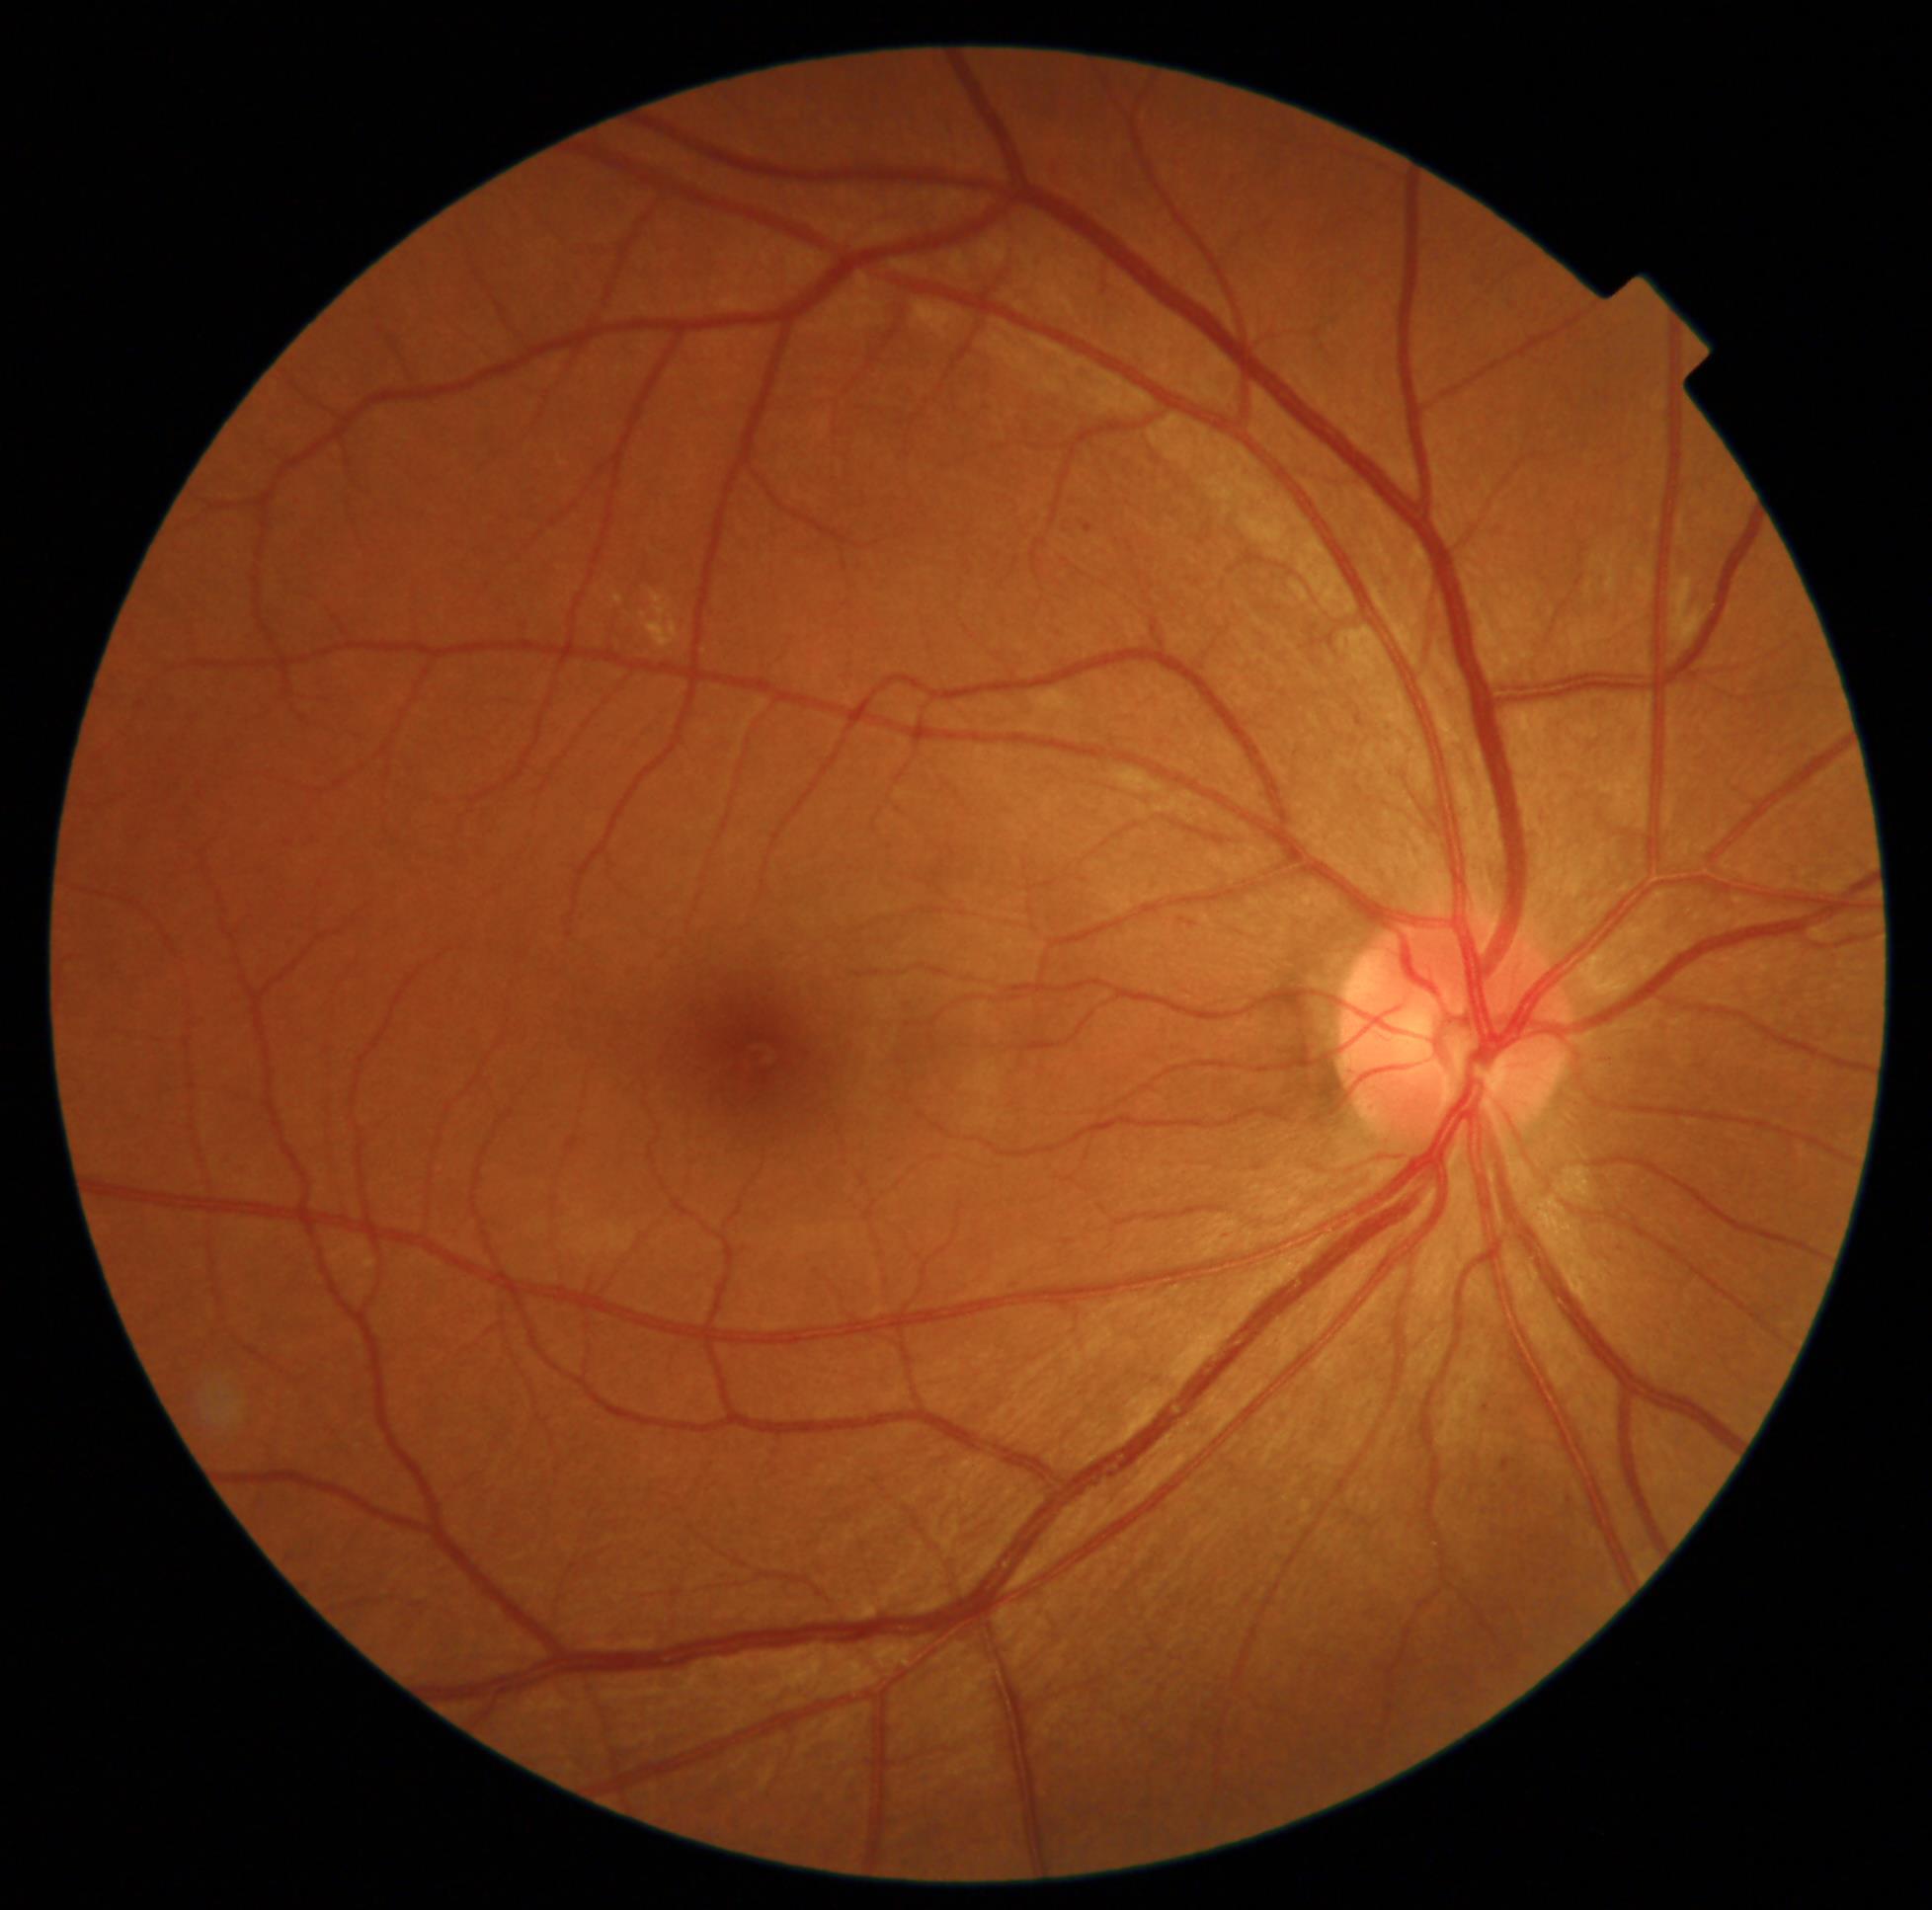
DR stage@moderate NPDR (grade 2); DR class@non-proliferative diabetic retinopathy.